1240x1240px. Pediatric retinal photograph (wide-field) — 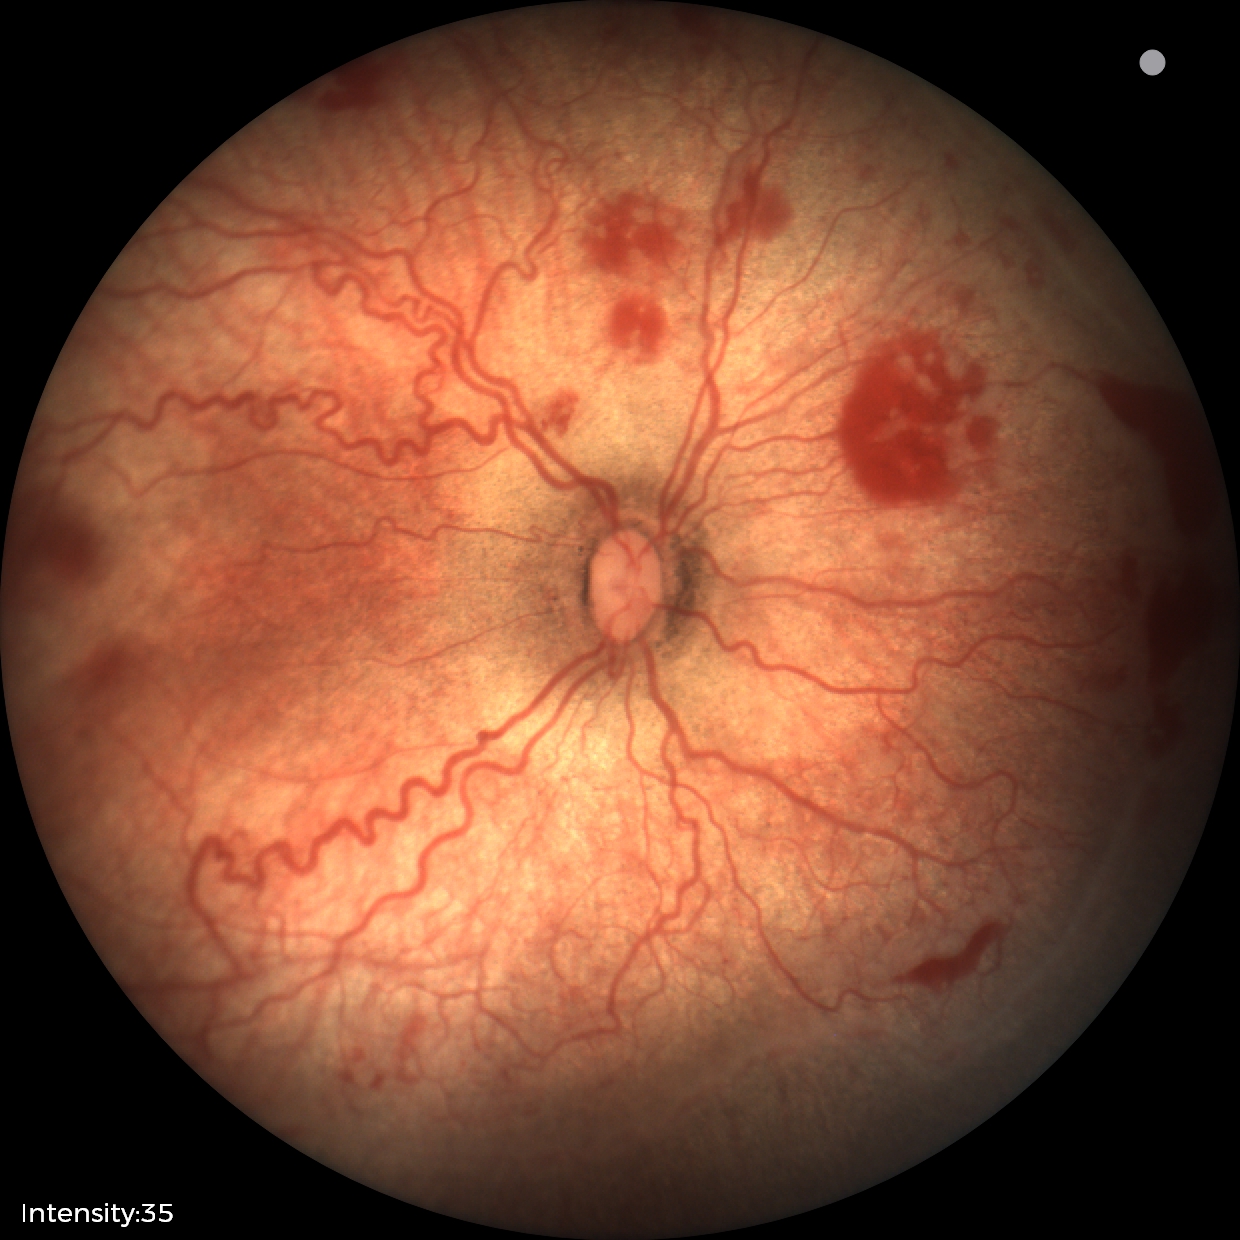

From an examination with diagnosis of retinopathy of prematurity (ROP) stage 2.